Graded on the modified Davis scale
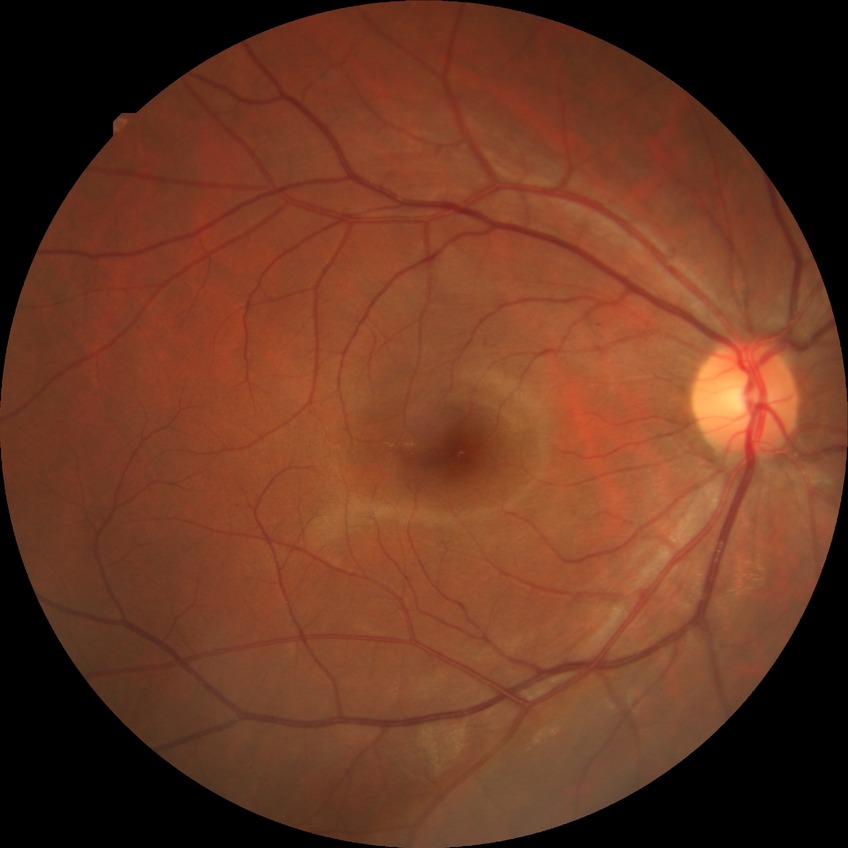 Retinopathy grade: simple diabetic retinopathy.